Topcon TRC-50DX — 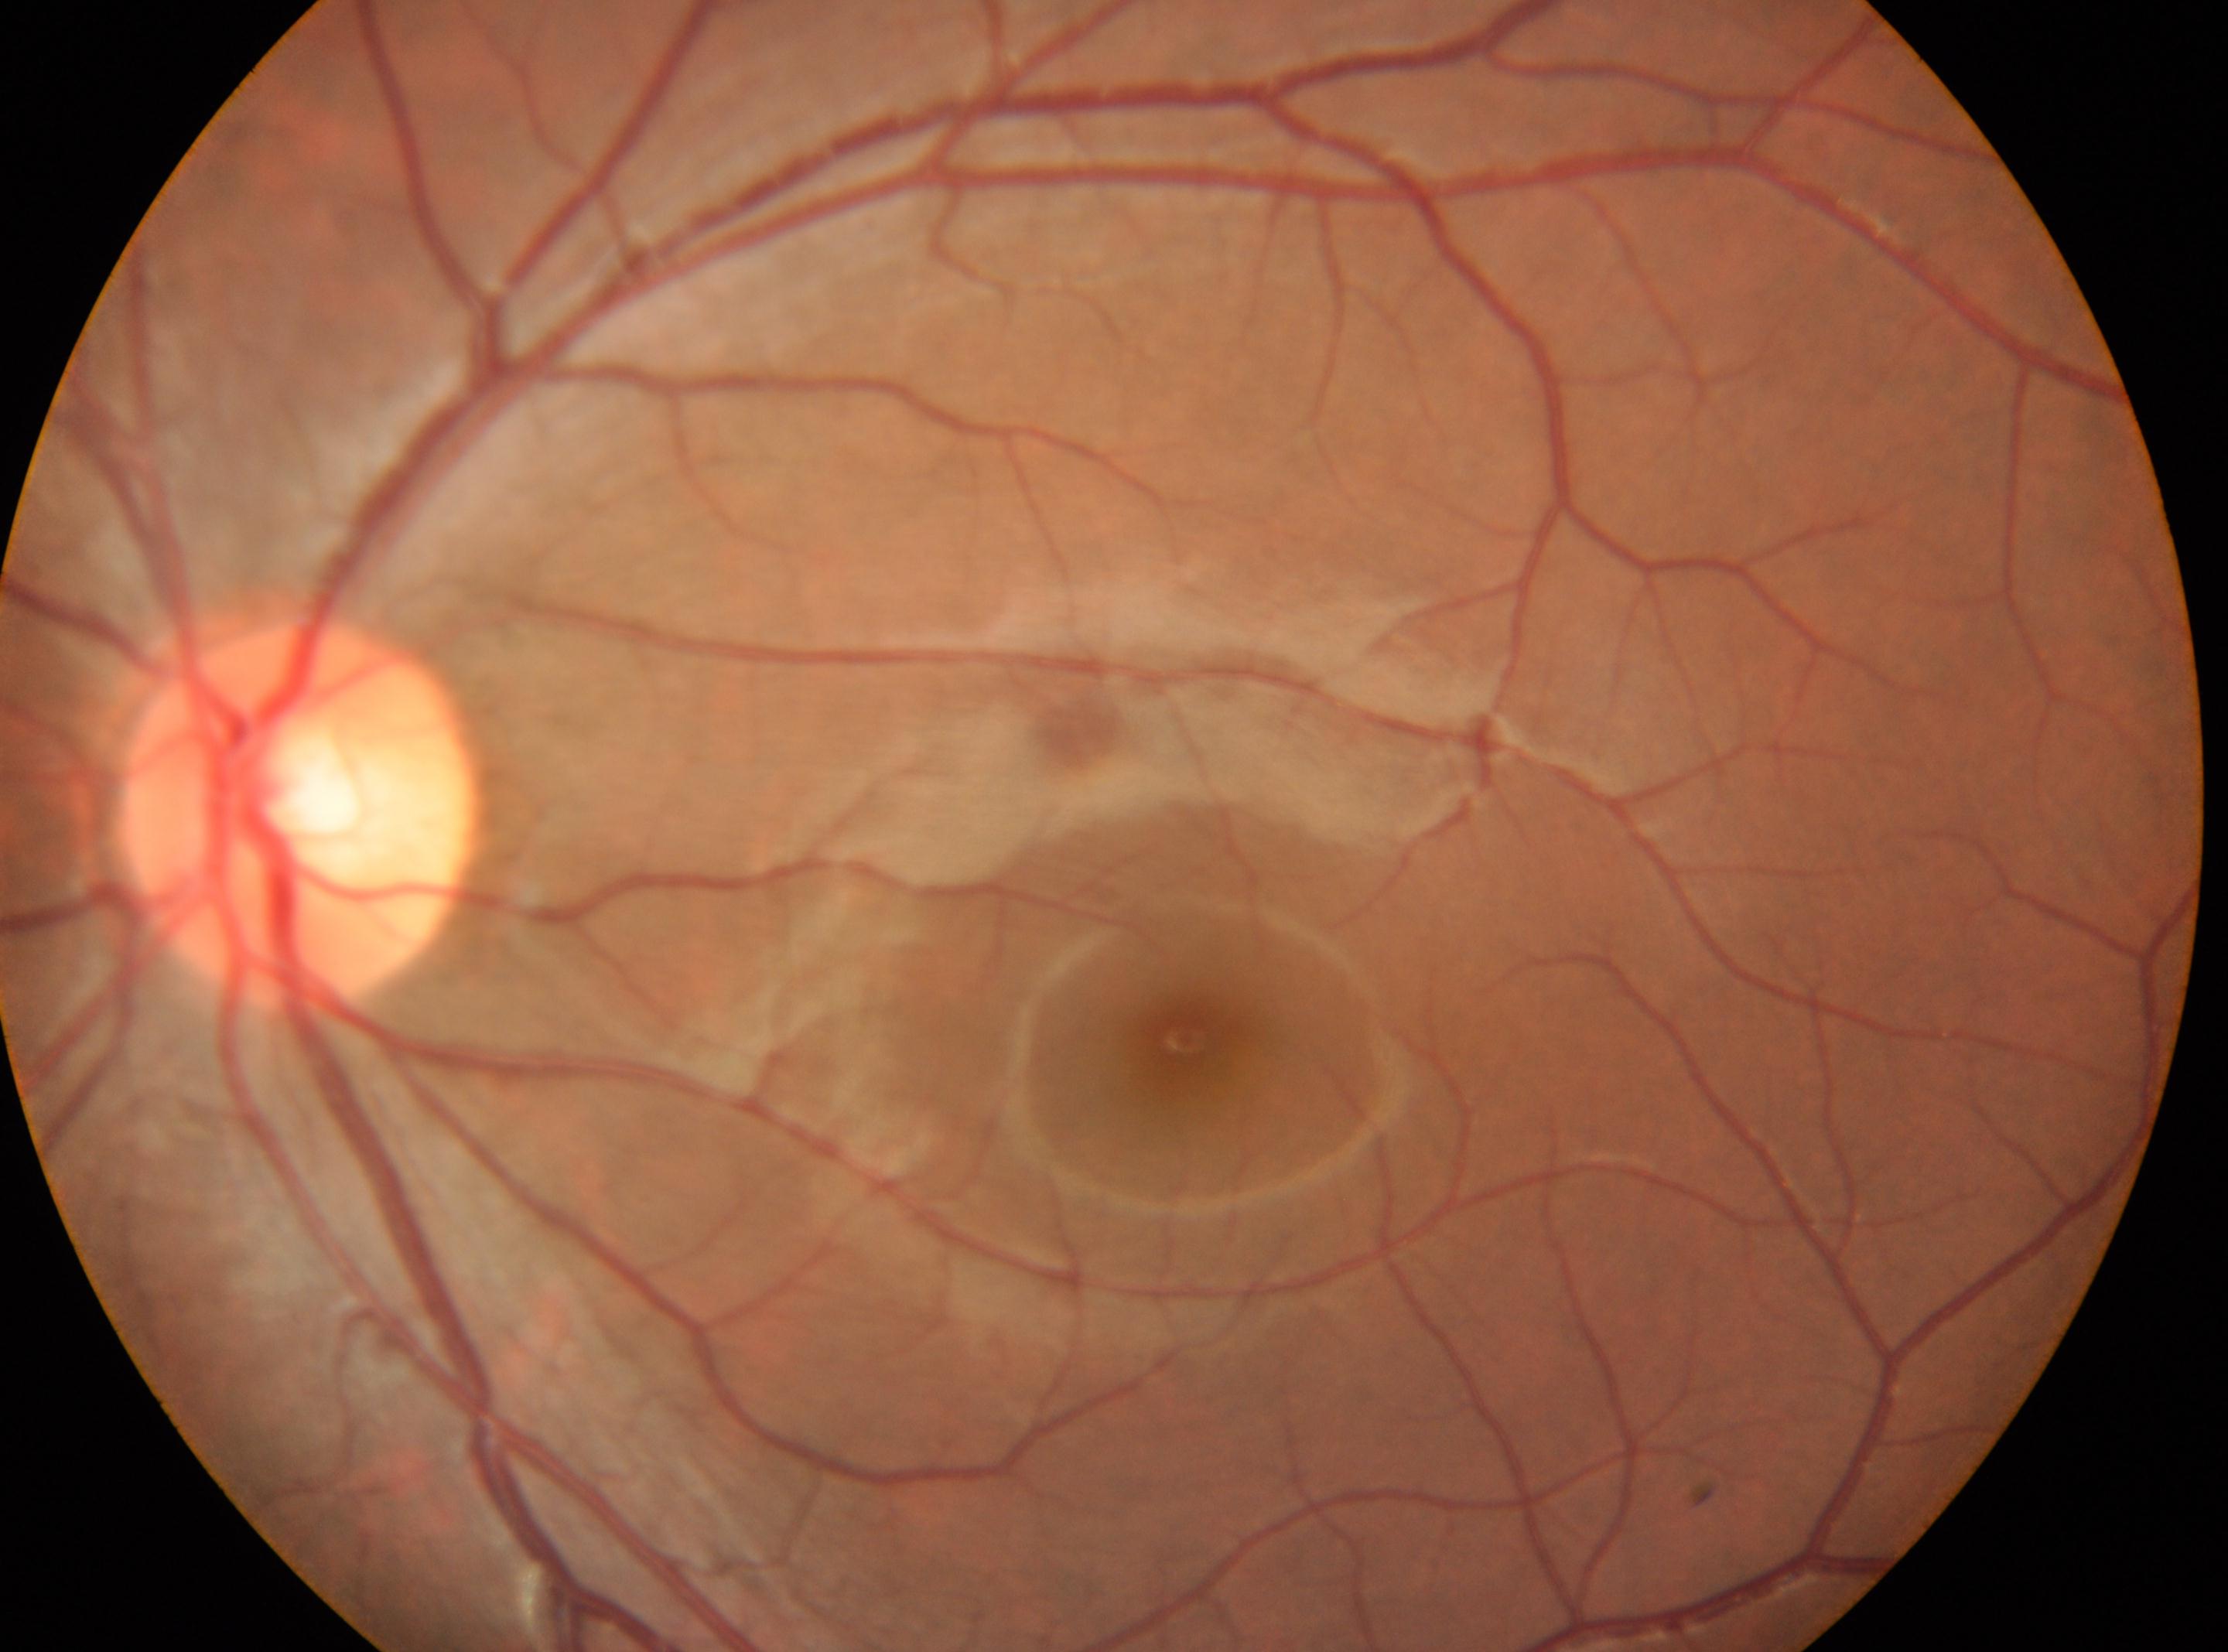

left | disc center@[300, 817] | DR grade@no apparent retinopathy (0) | No DR findings | fovea centralis@[1185, 1038].